45° field of view — 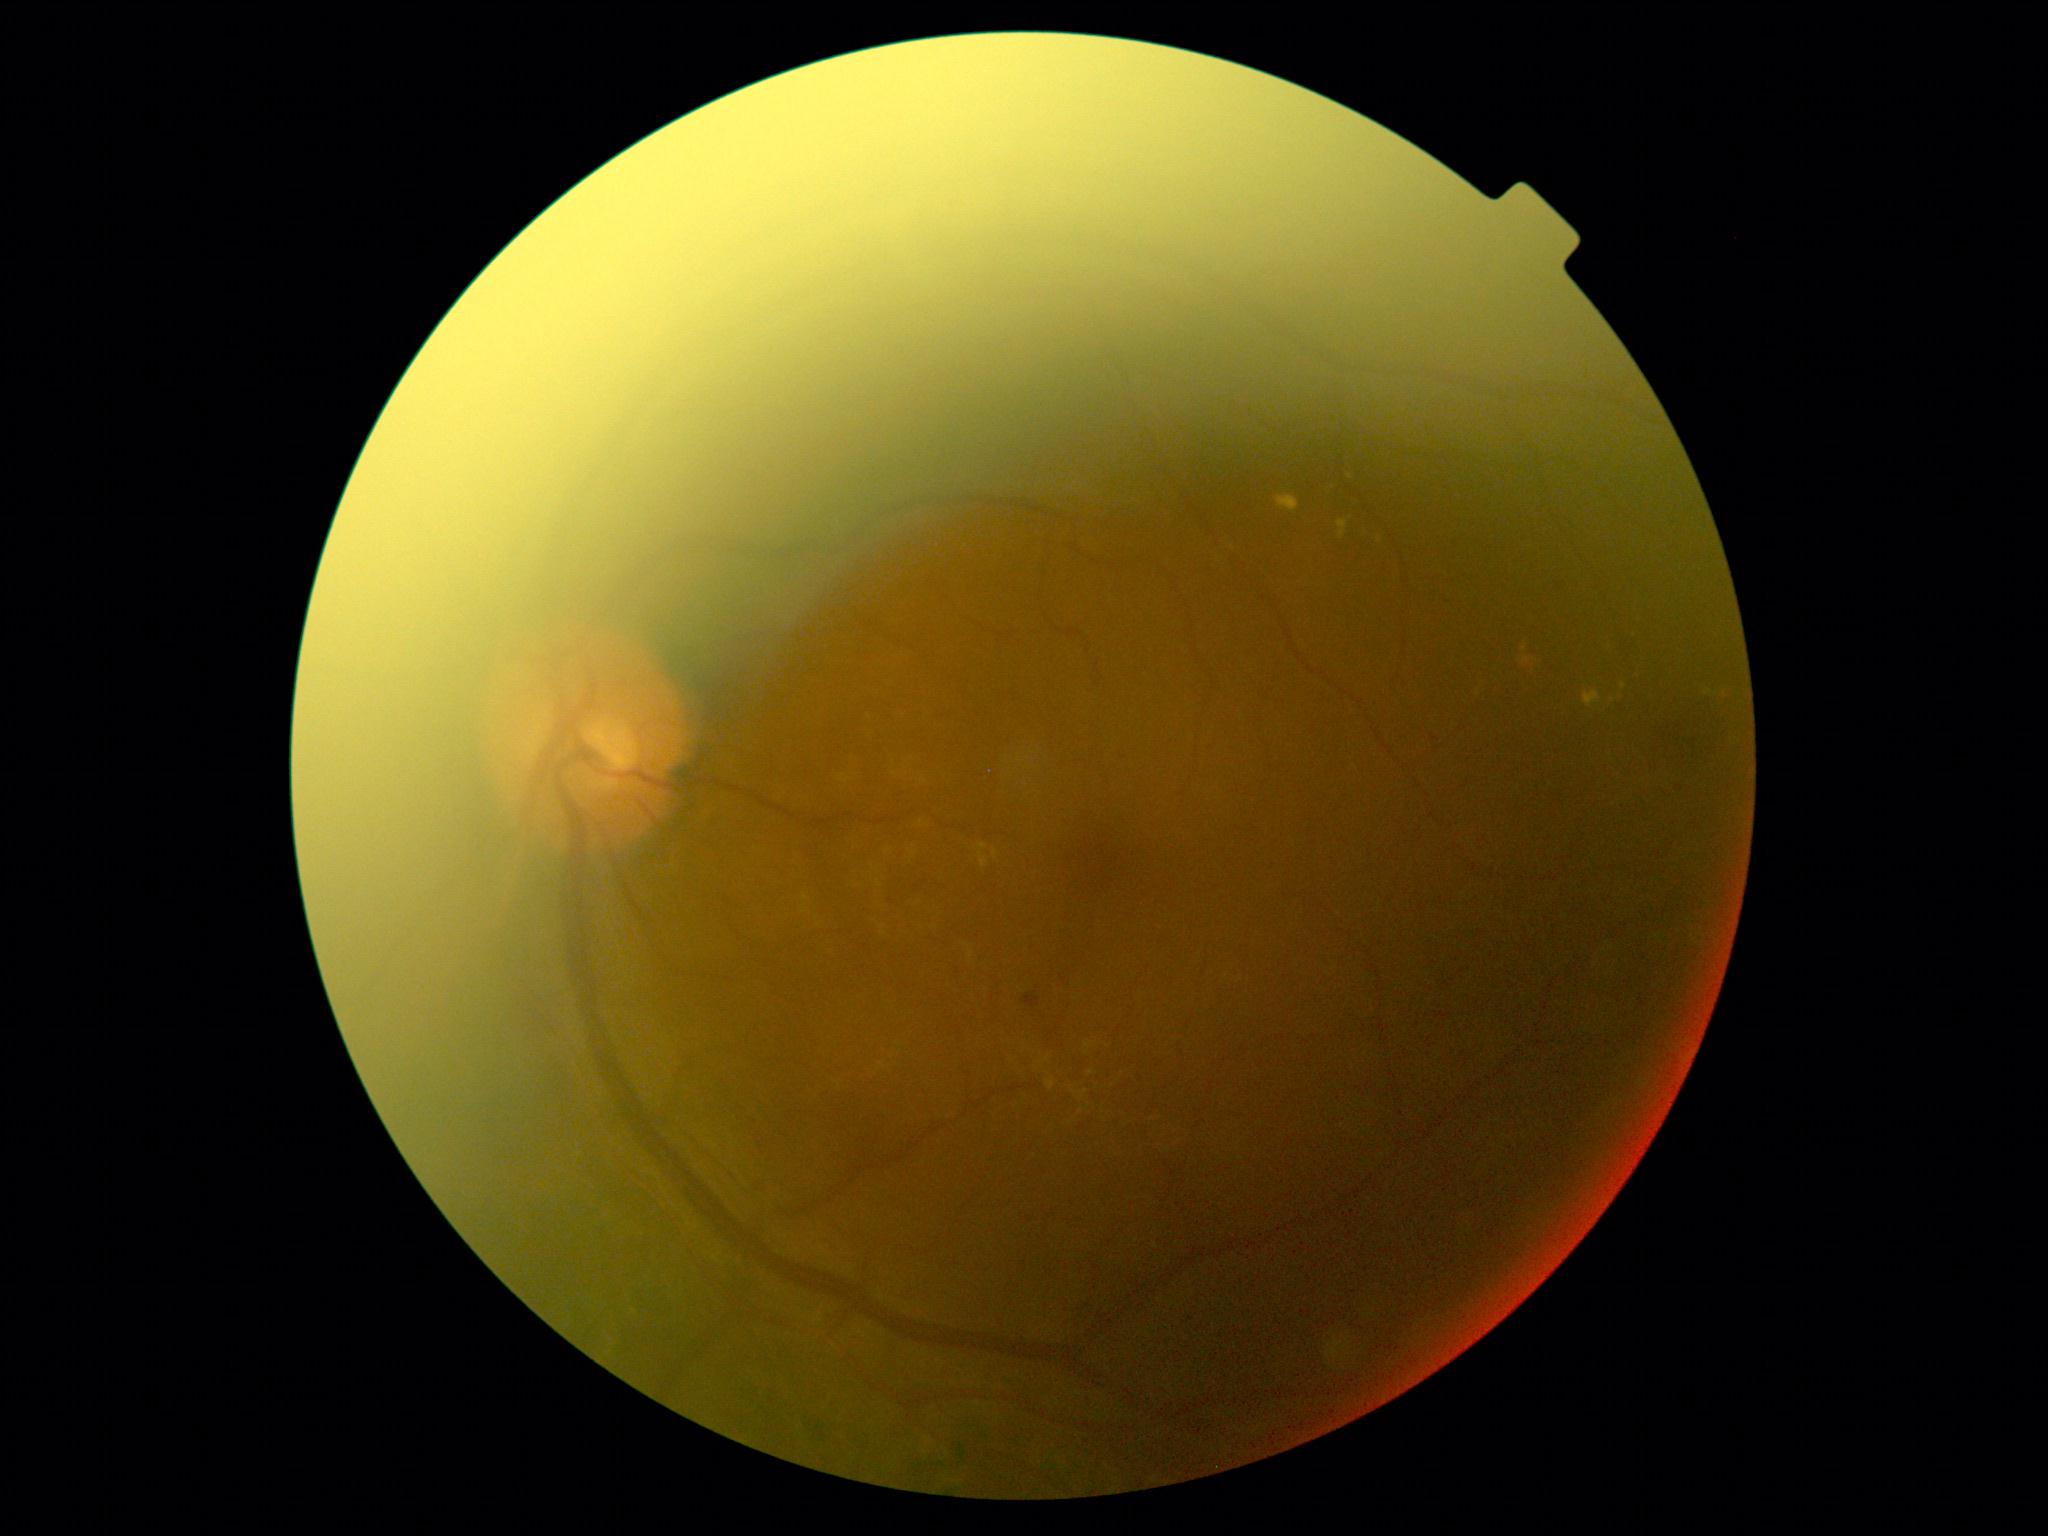
DR class@non-proliferative diabetic retinopathy, DR@grade 2 (moderate NPDR).